Image size 2352x1568. Fundus photo. 45° field of view:
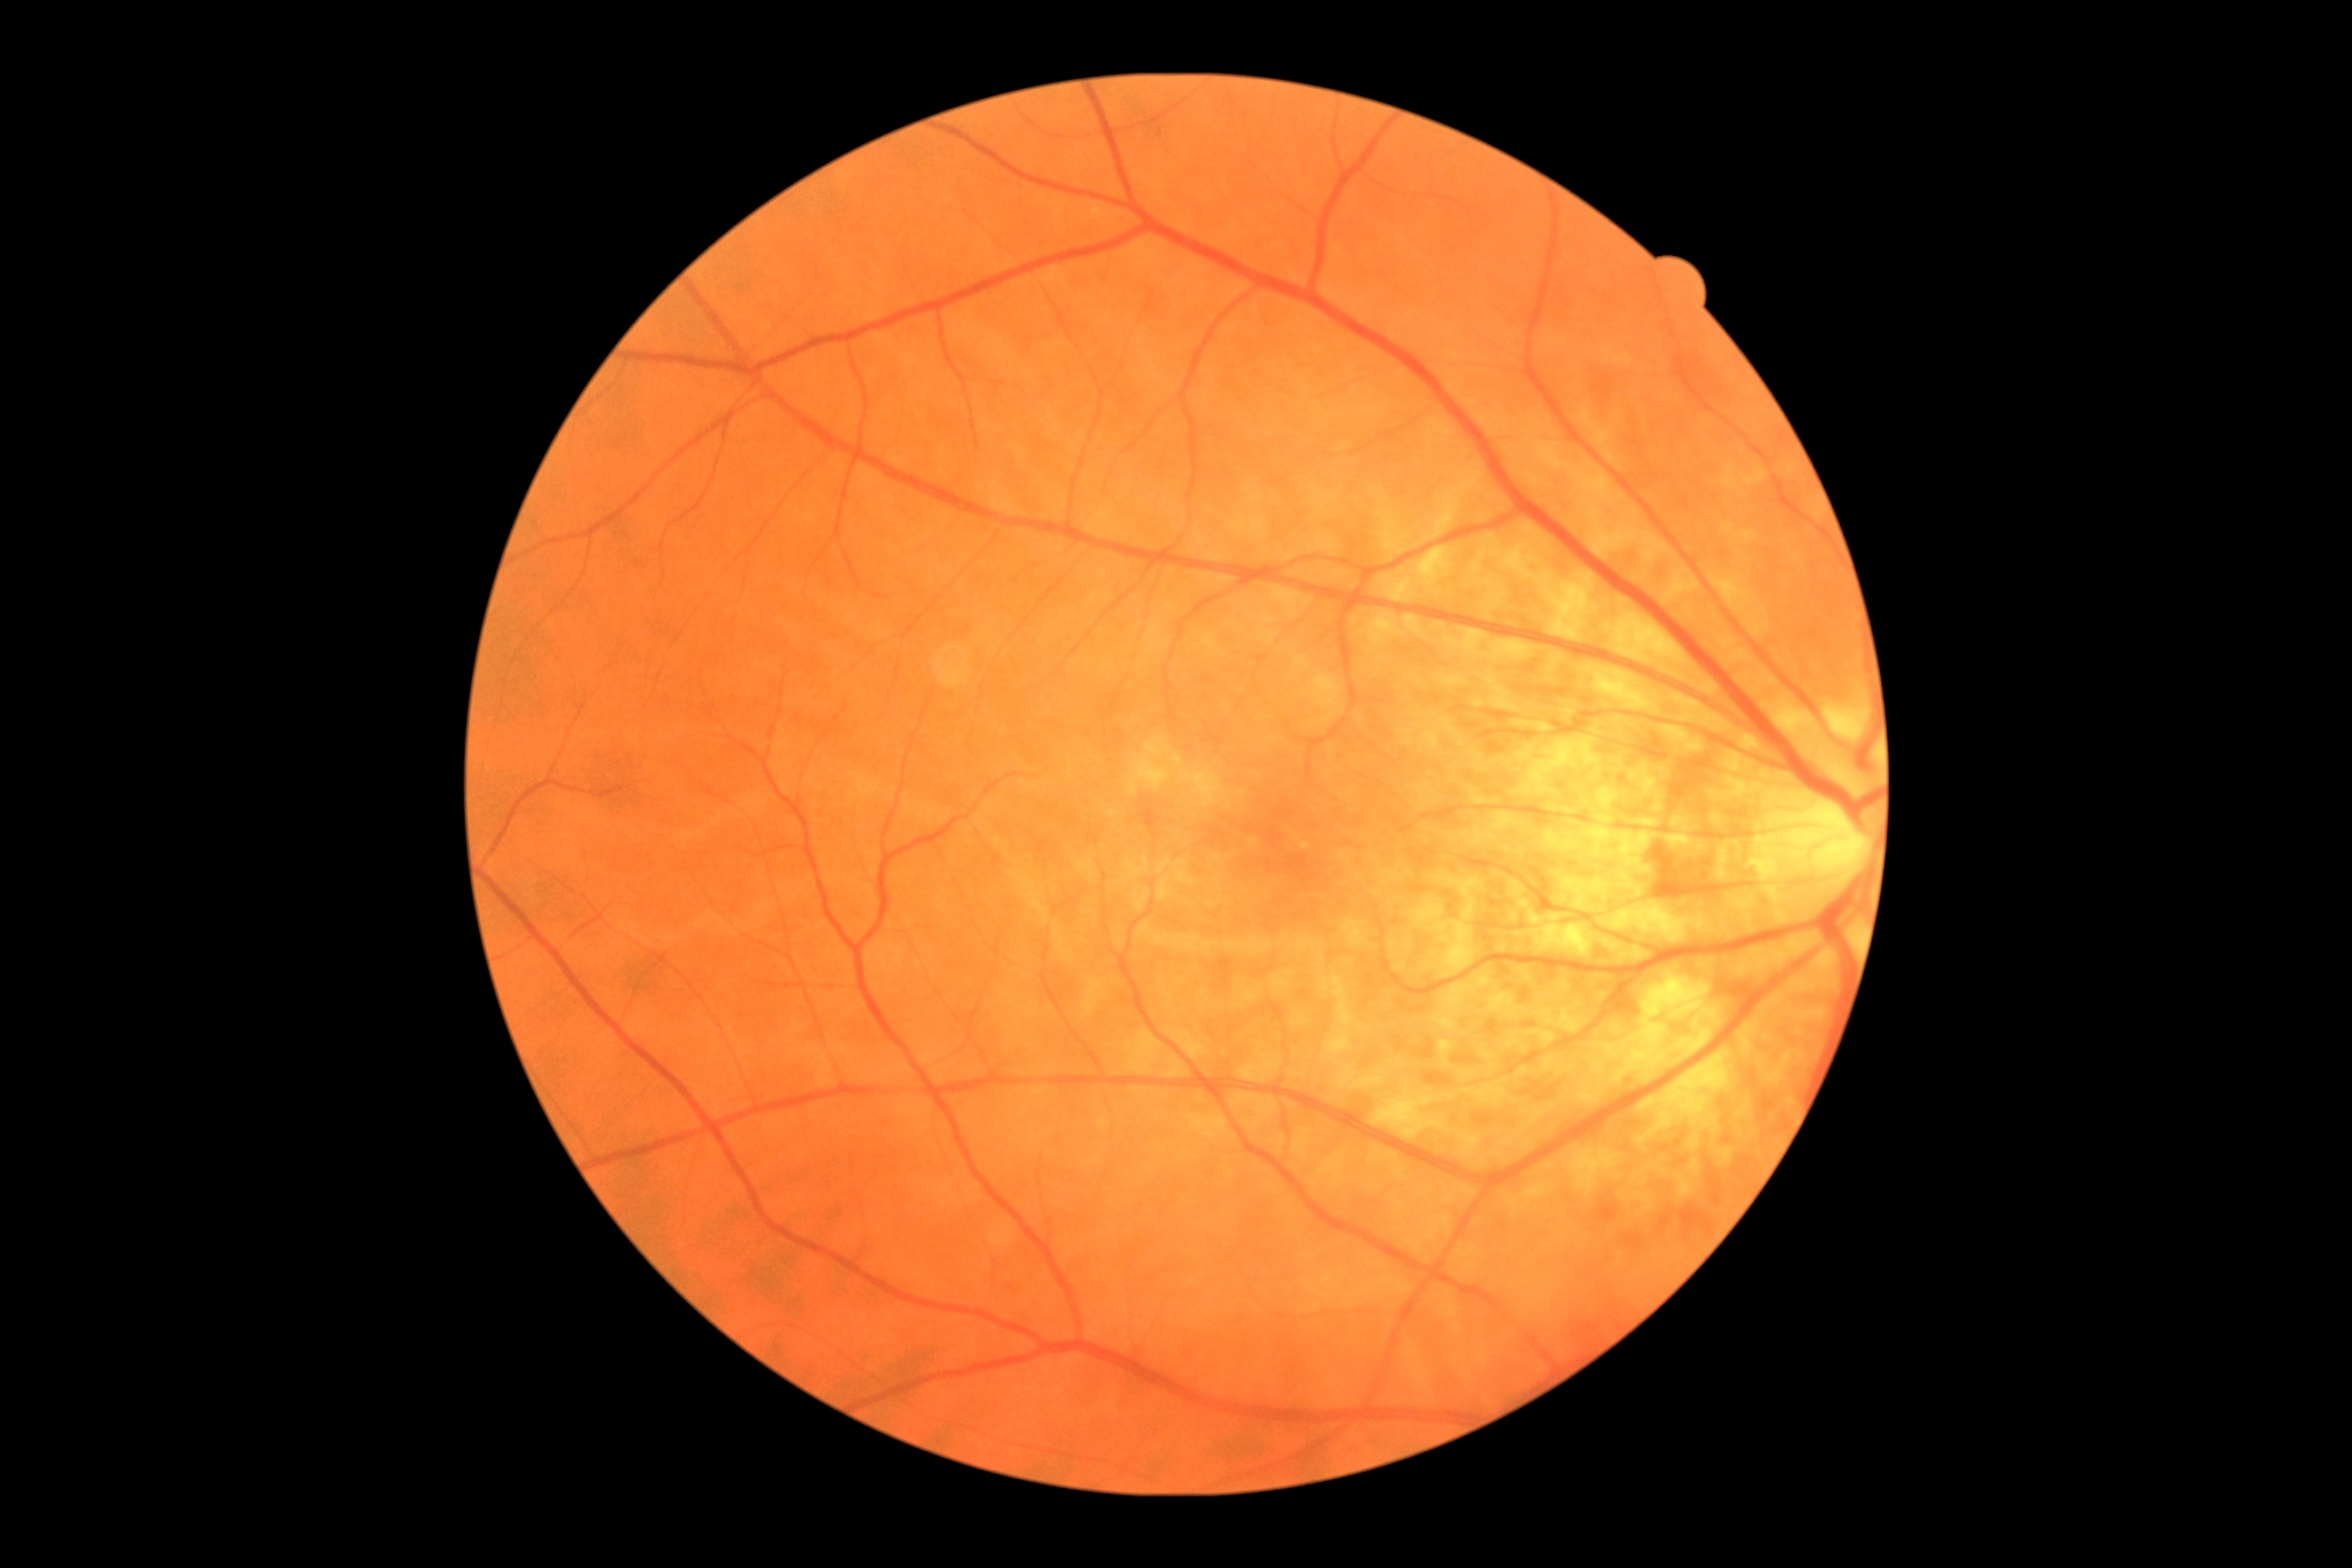

Retinopathy: 0.
No diabetic retinal disease findings.